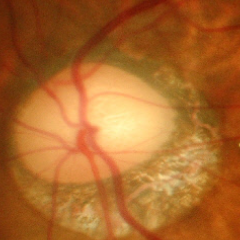

Glaucomatous optic neuropathy is present. This fundus photograph shows advanced glaucomatous optic neuropathy. Diagnostic criteria: near-total cupping of the optic nerve head, with or without severe visual field loss within the central 10 degrees of fixation.